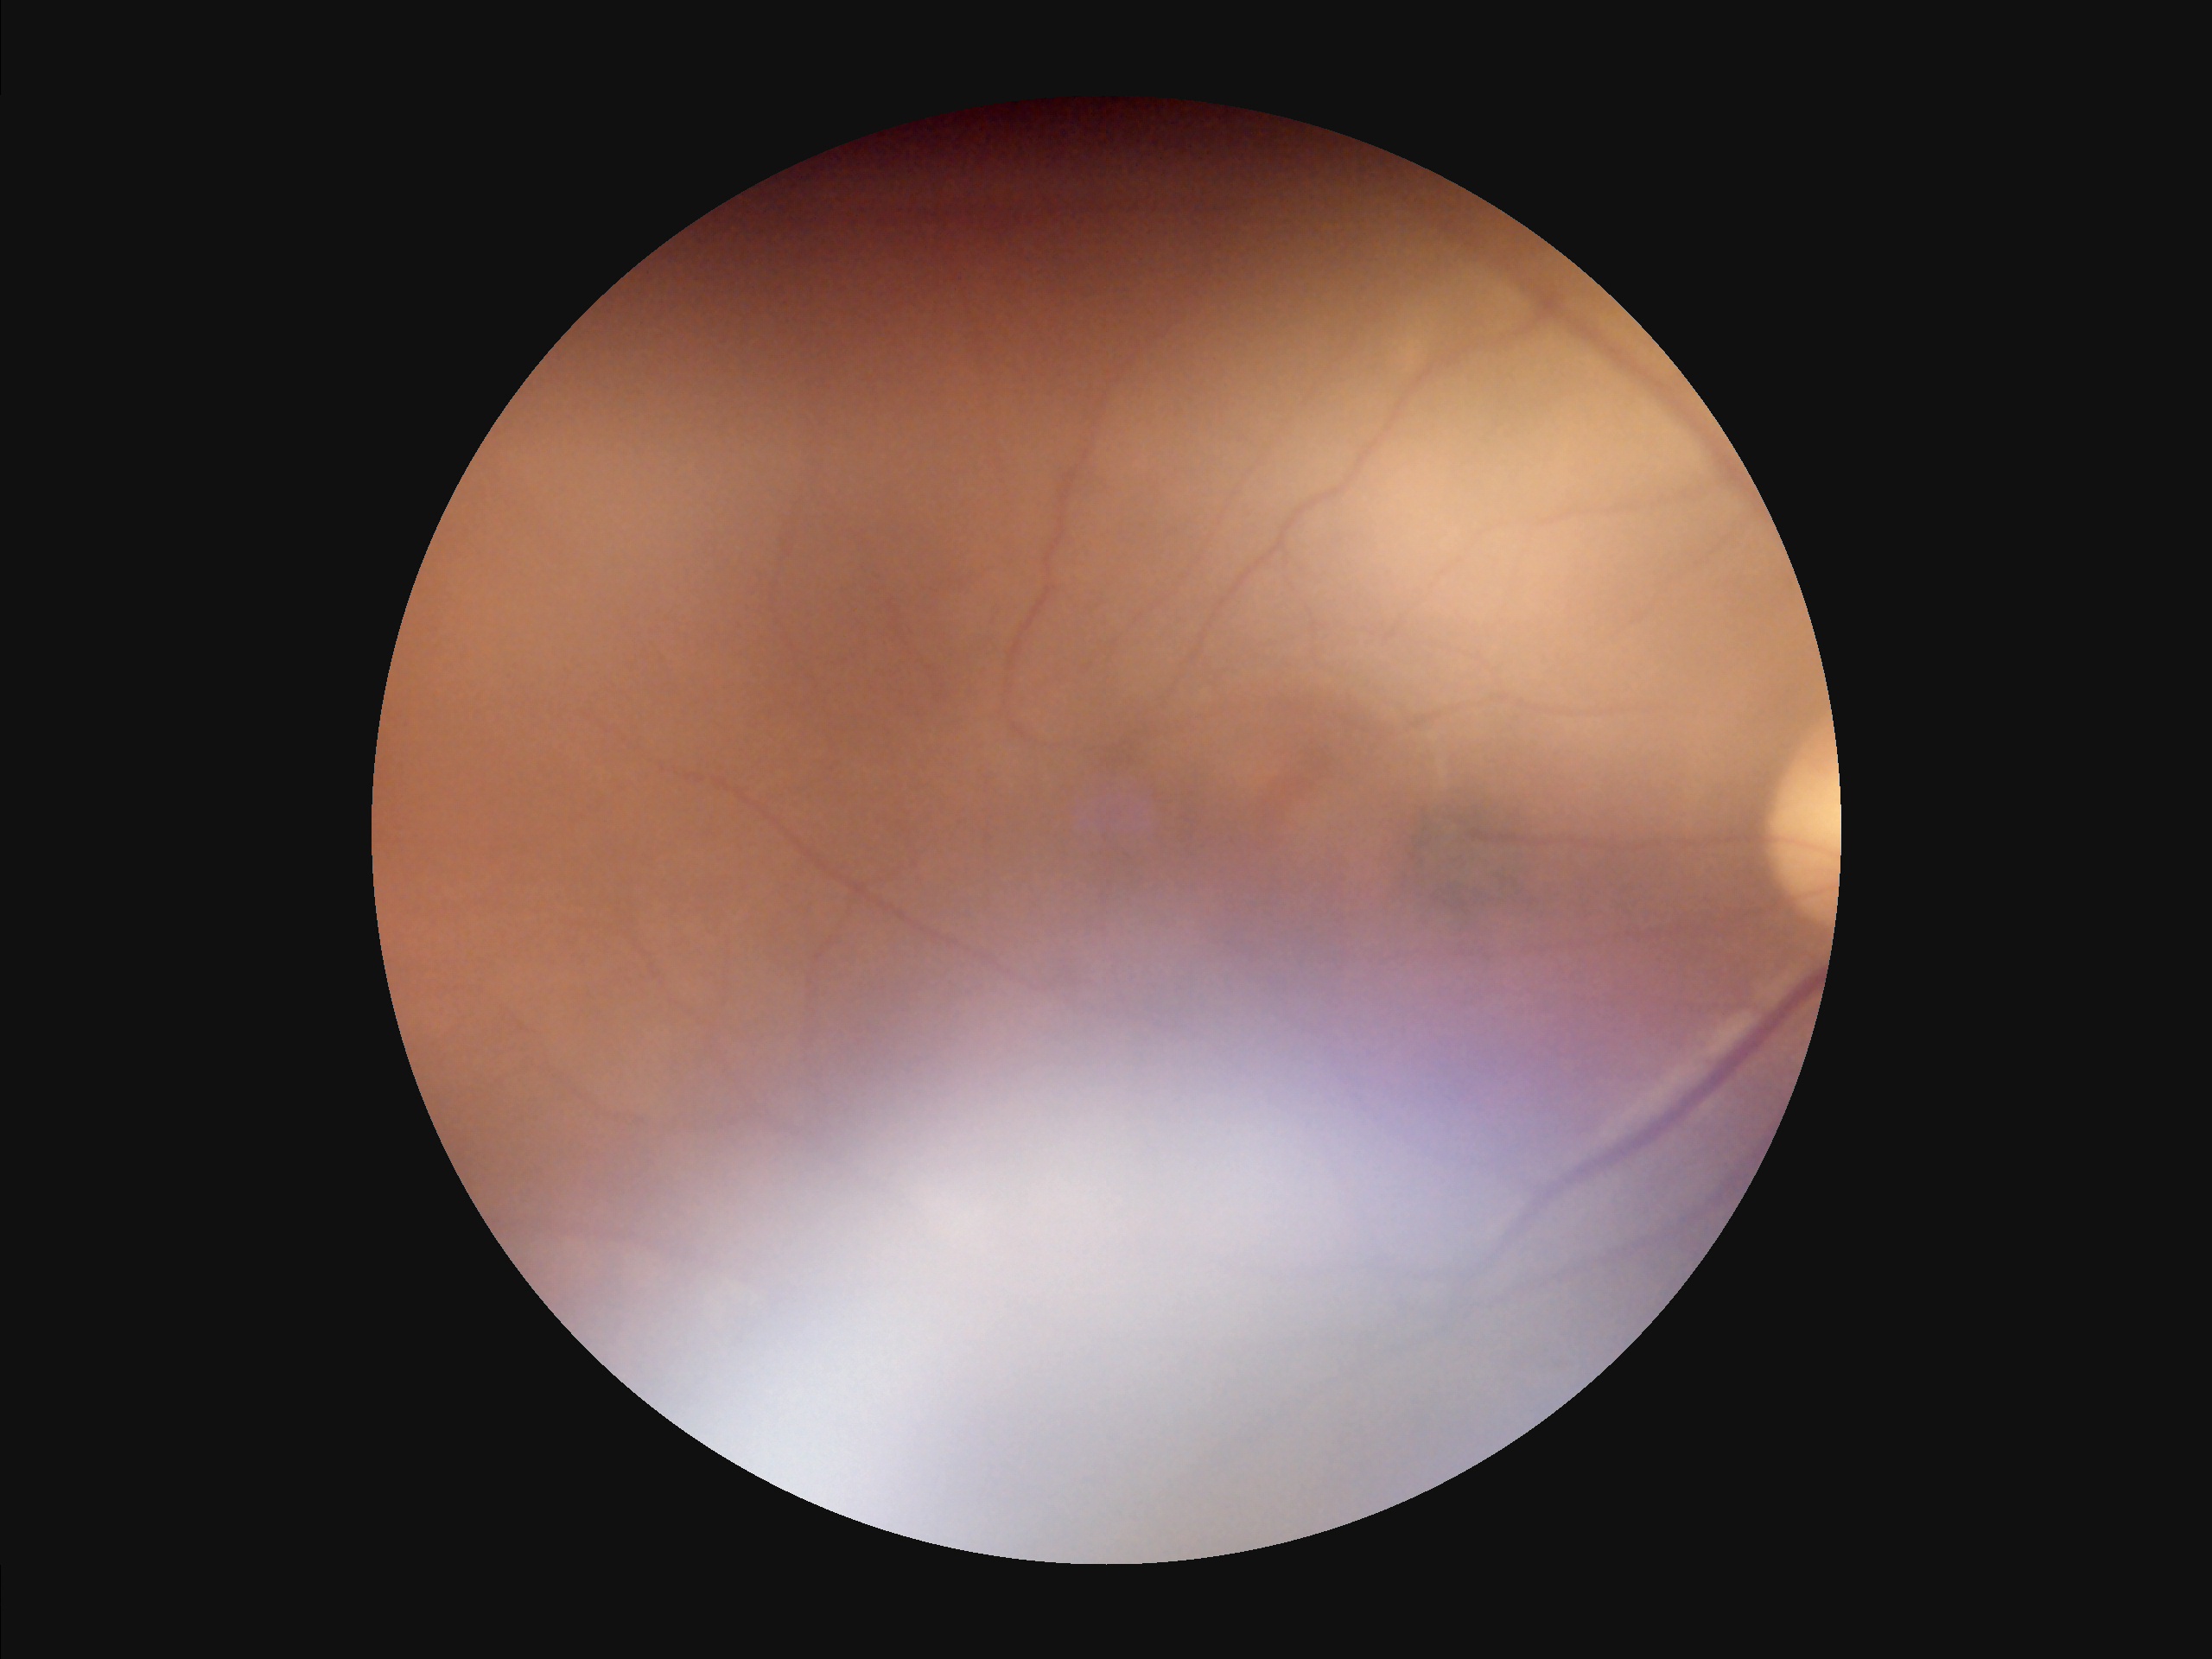 Out of focus; structures are indistinct. Narrow intensity range; structures are hard to distinguish. Image quality is inadequate for diagnostic use. There is over- or under-exposure or a color cast.